Phoenix ICON wide-field infant fundus image · captured with the Phoenix ICON (100° field of view)
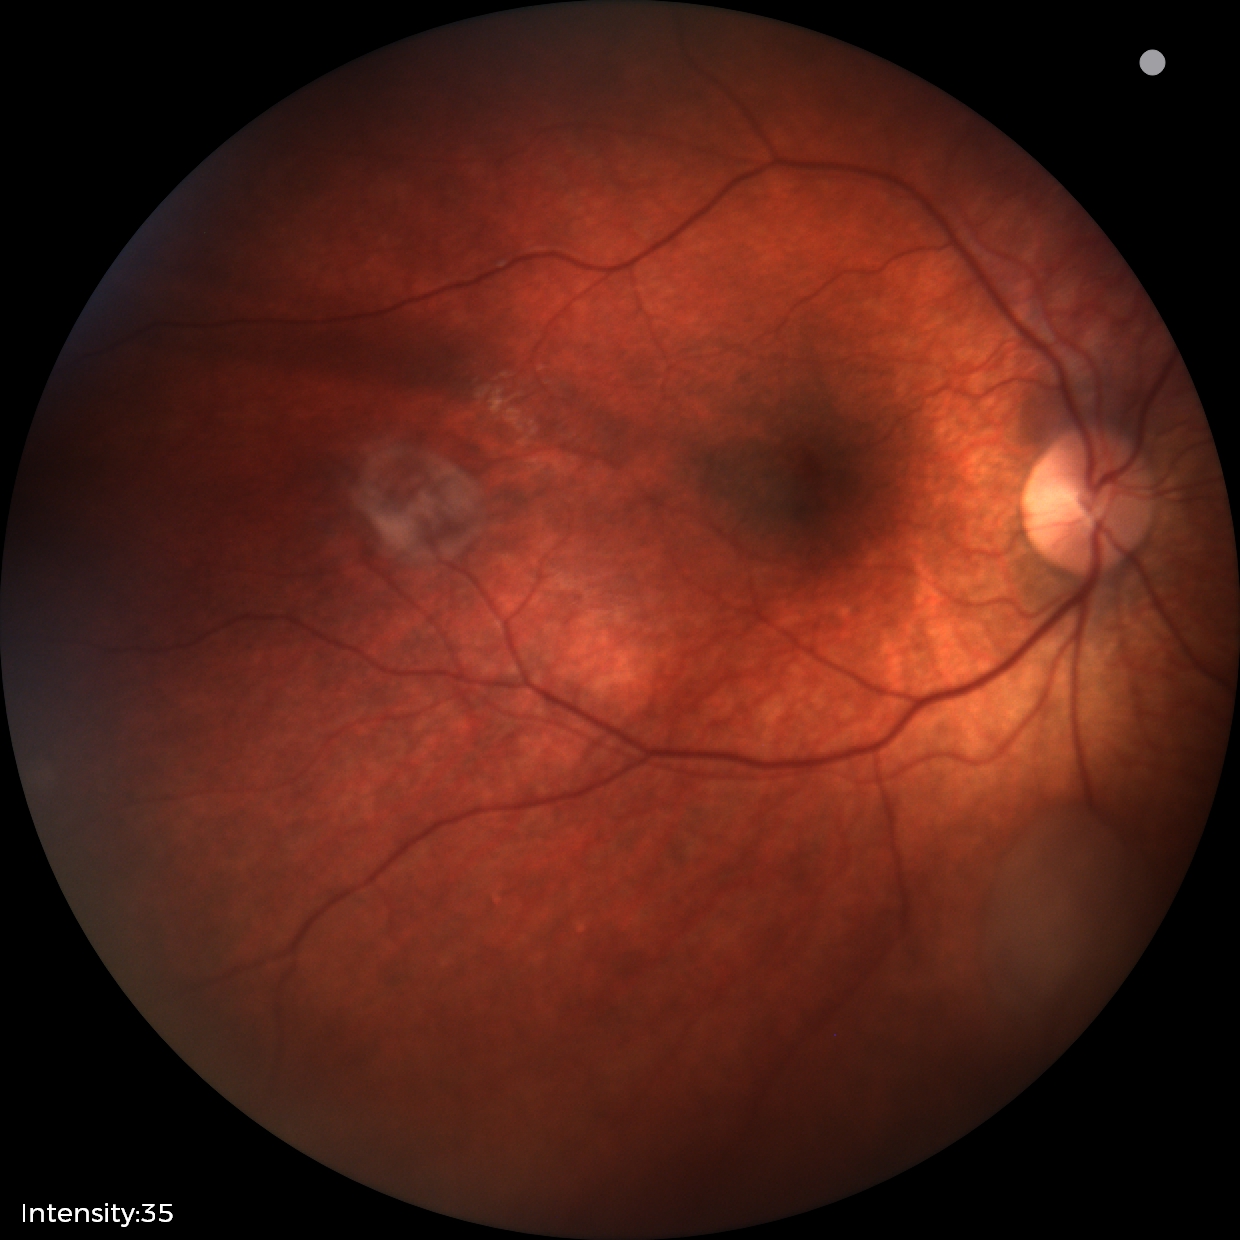

Impression: retinal astrocytic hamartoma.